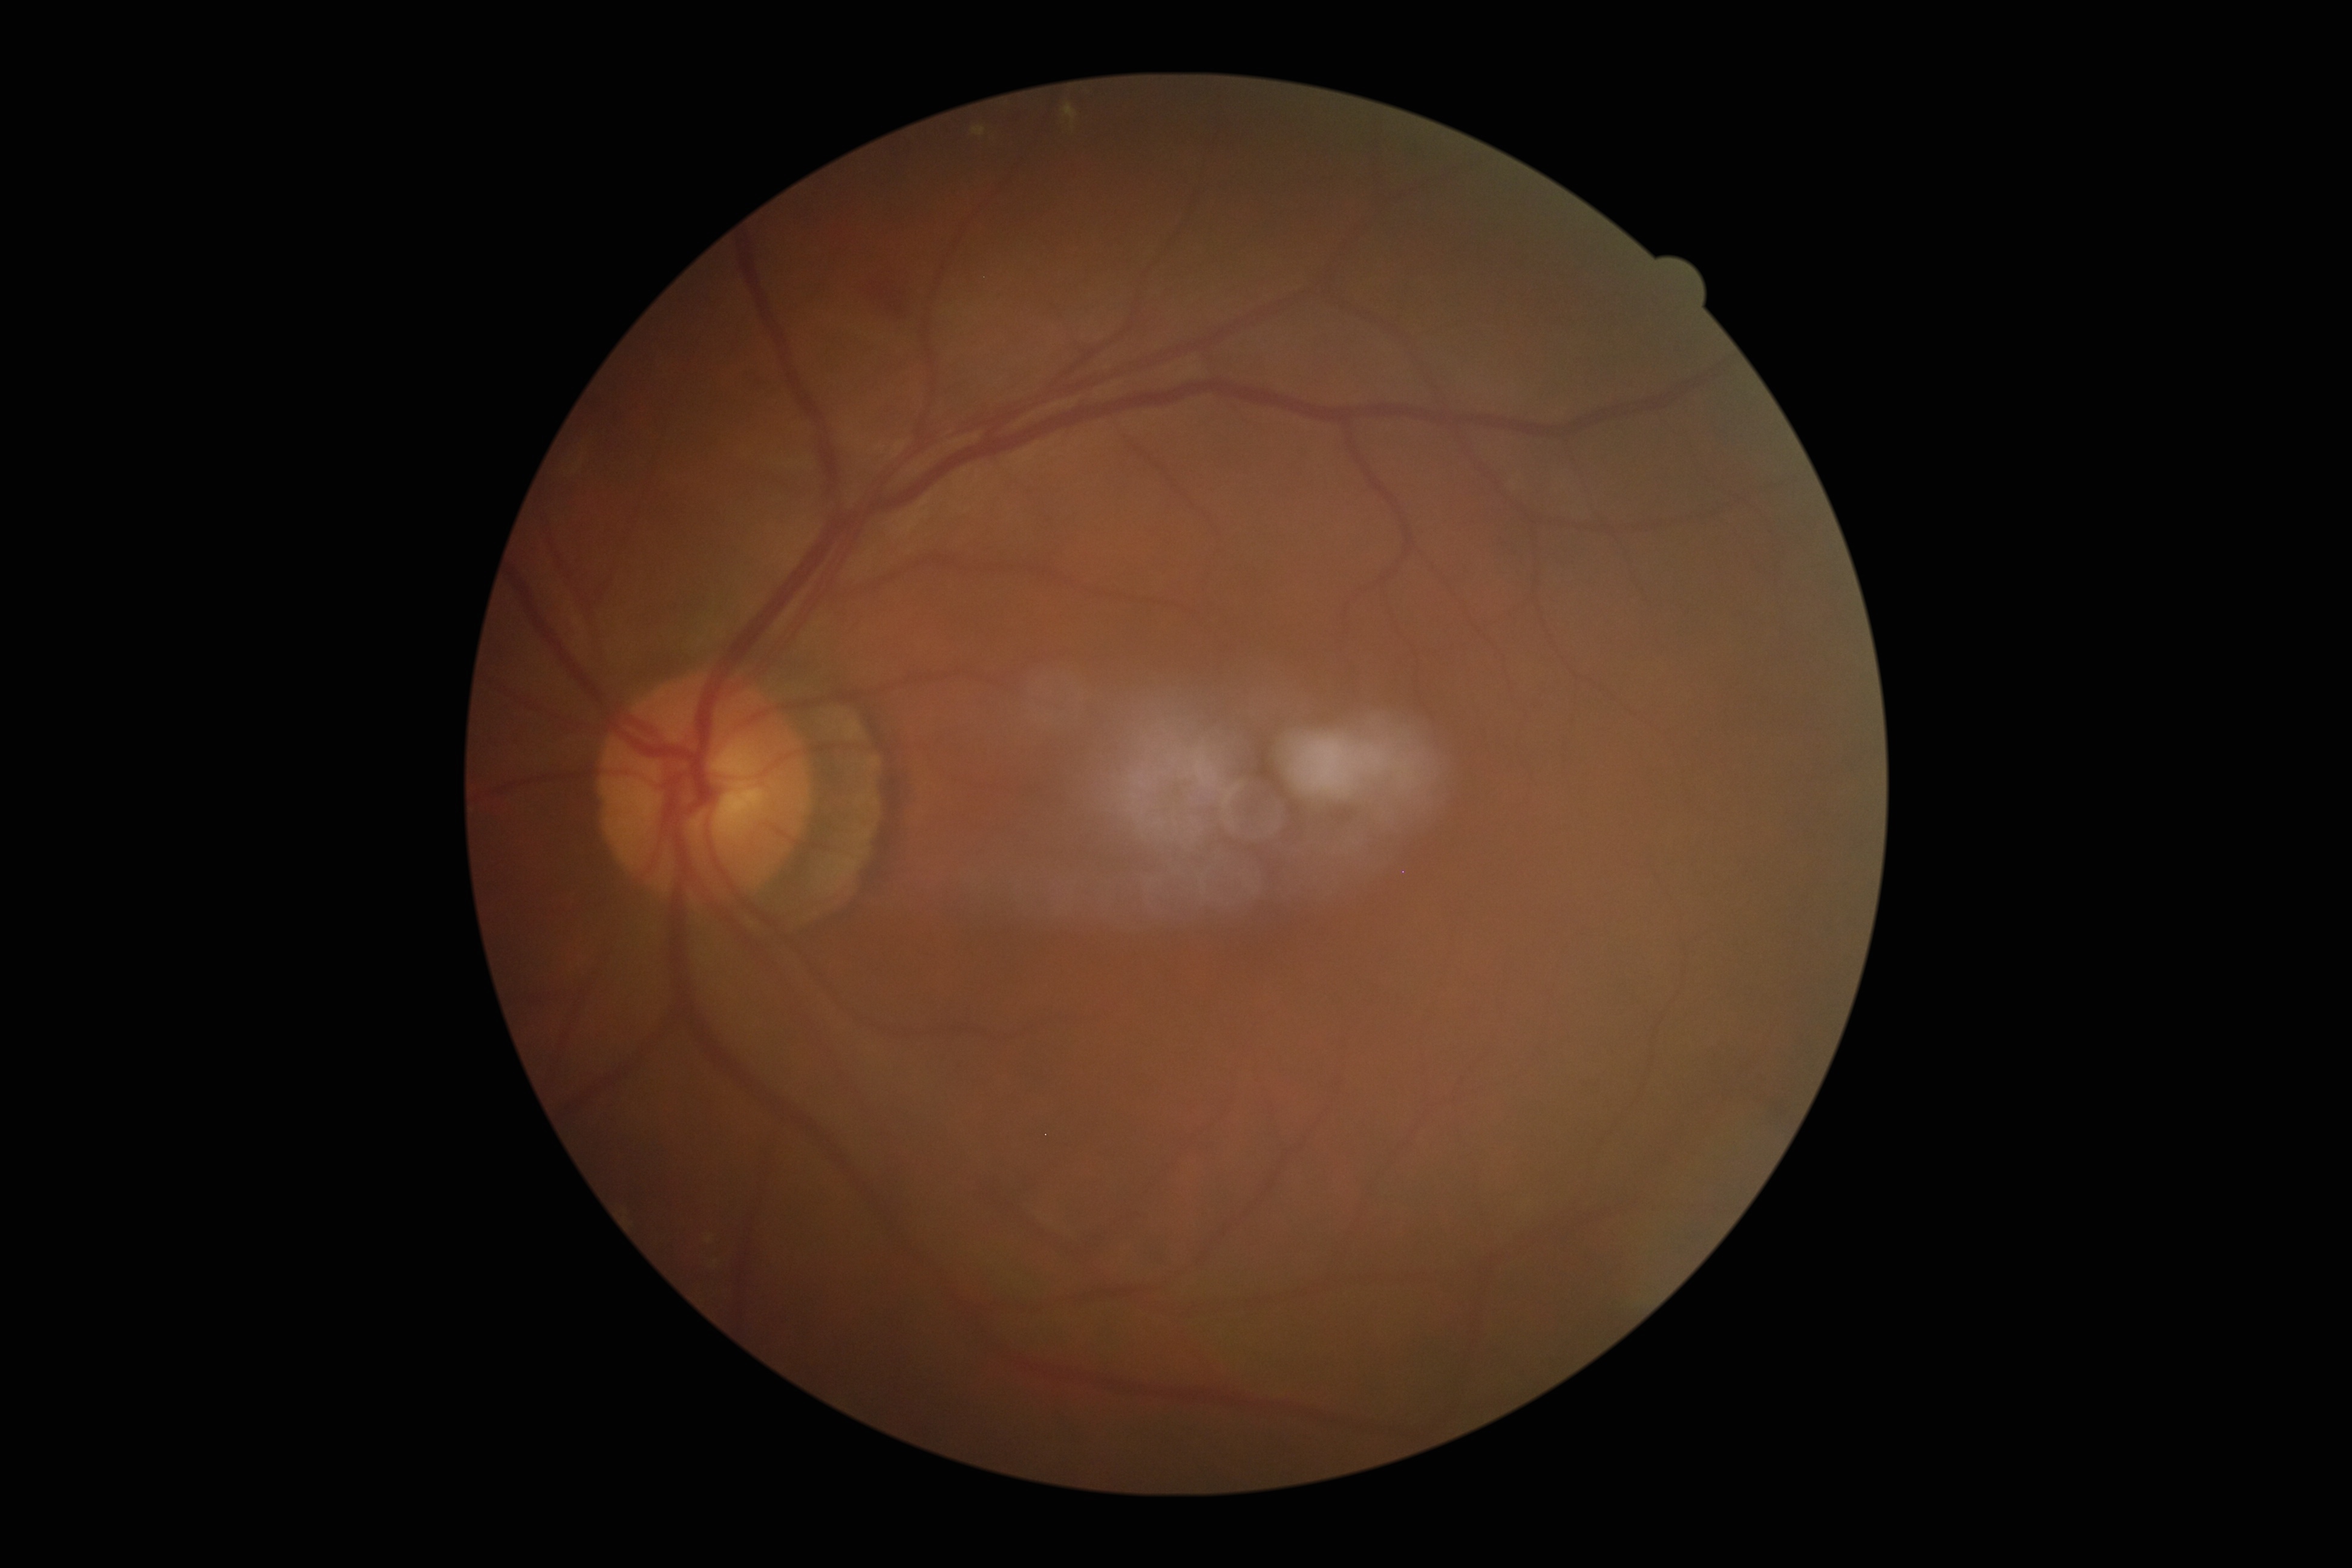
DR severity: grade 2 (moderate NPDR) — more than just microaneurysms but less than severe NPDR.